Captured on a Topcon TRC-NW8 fundus camera — 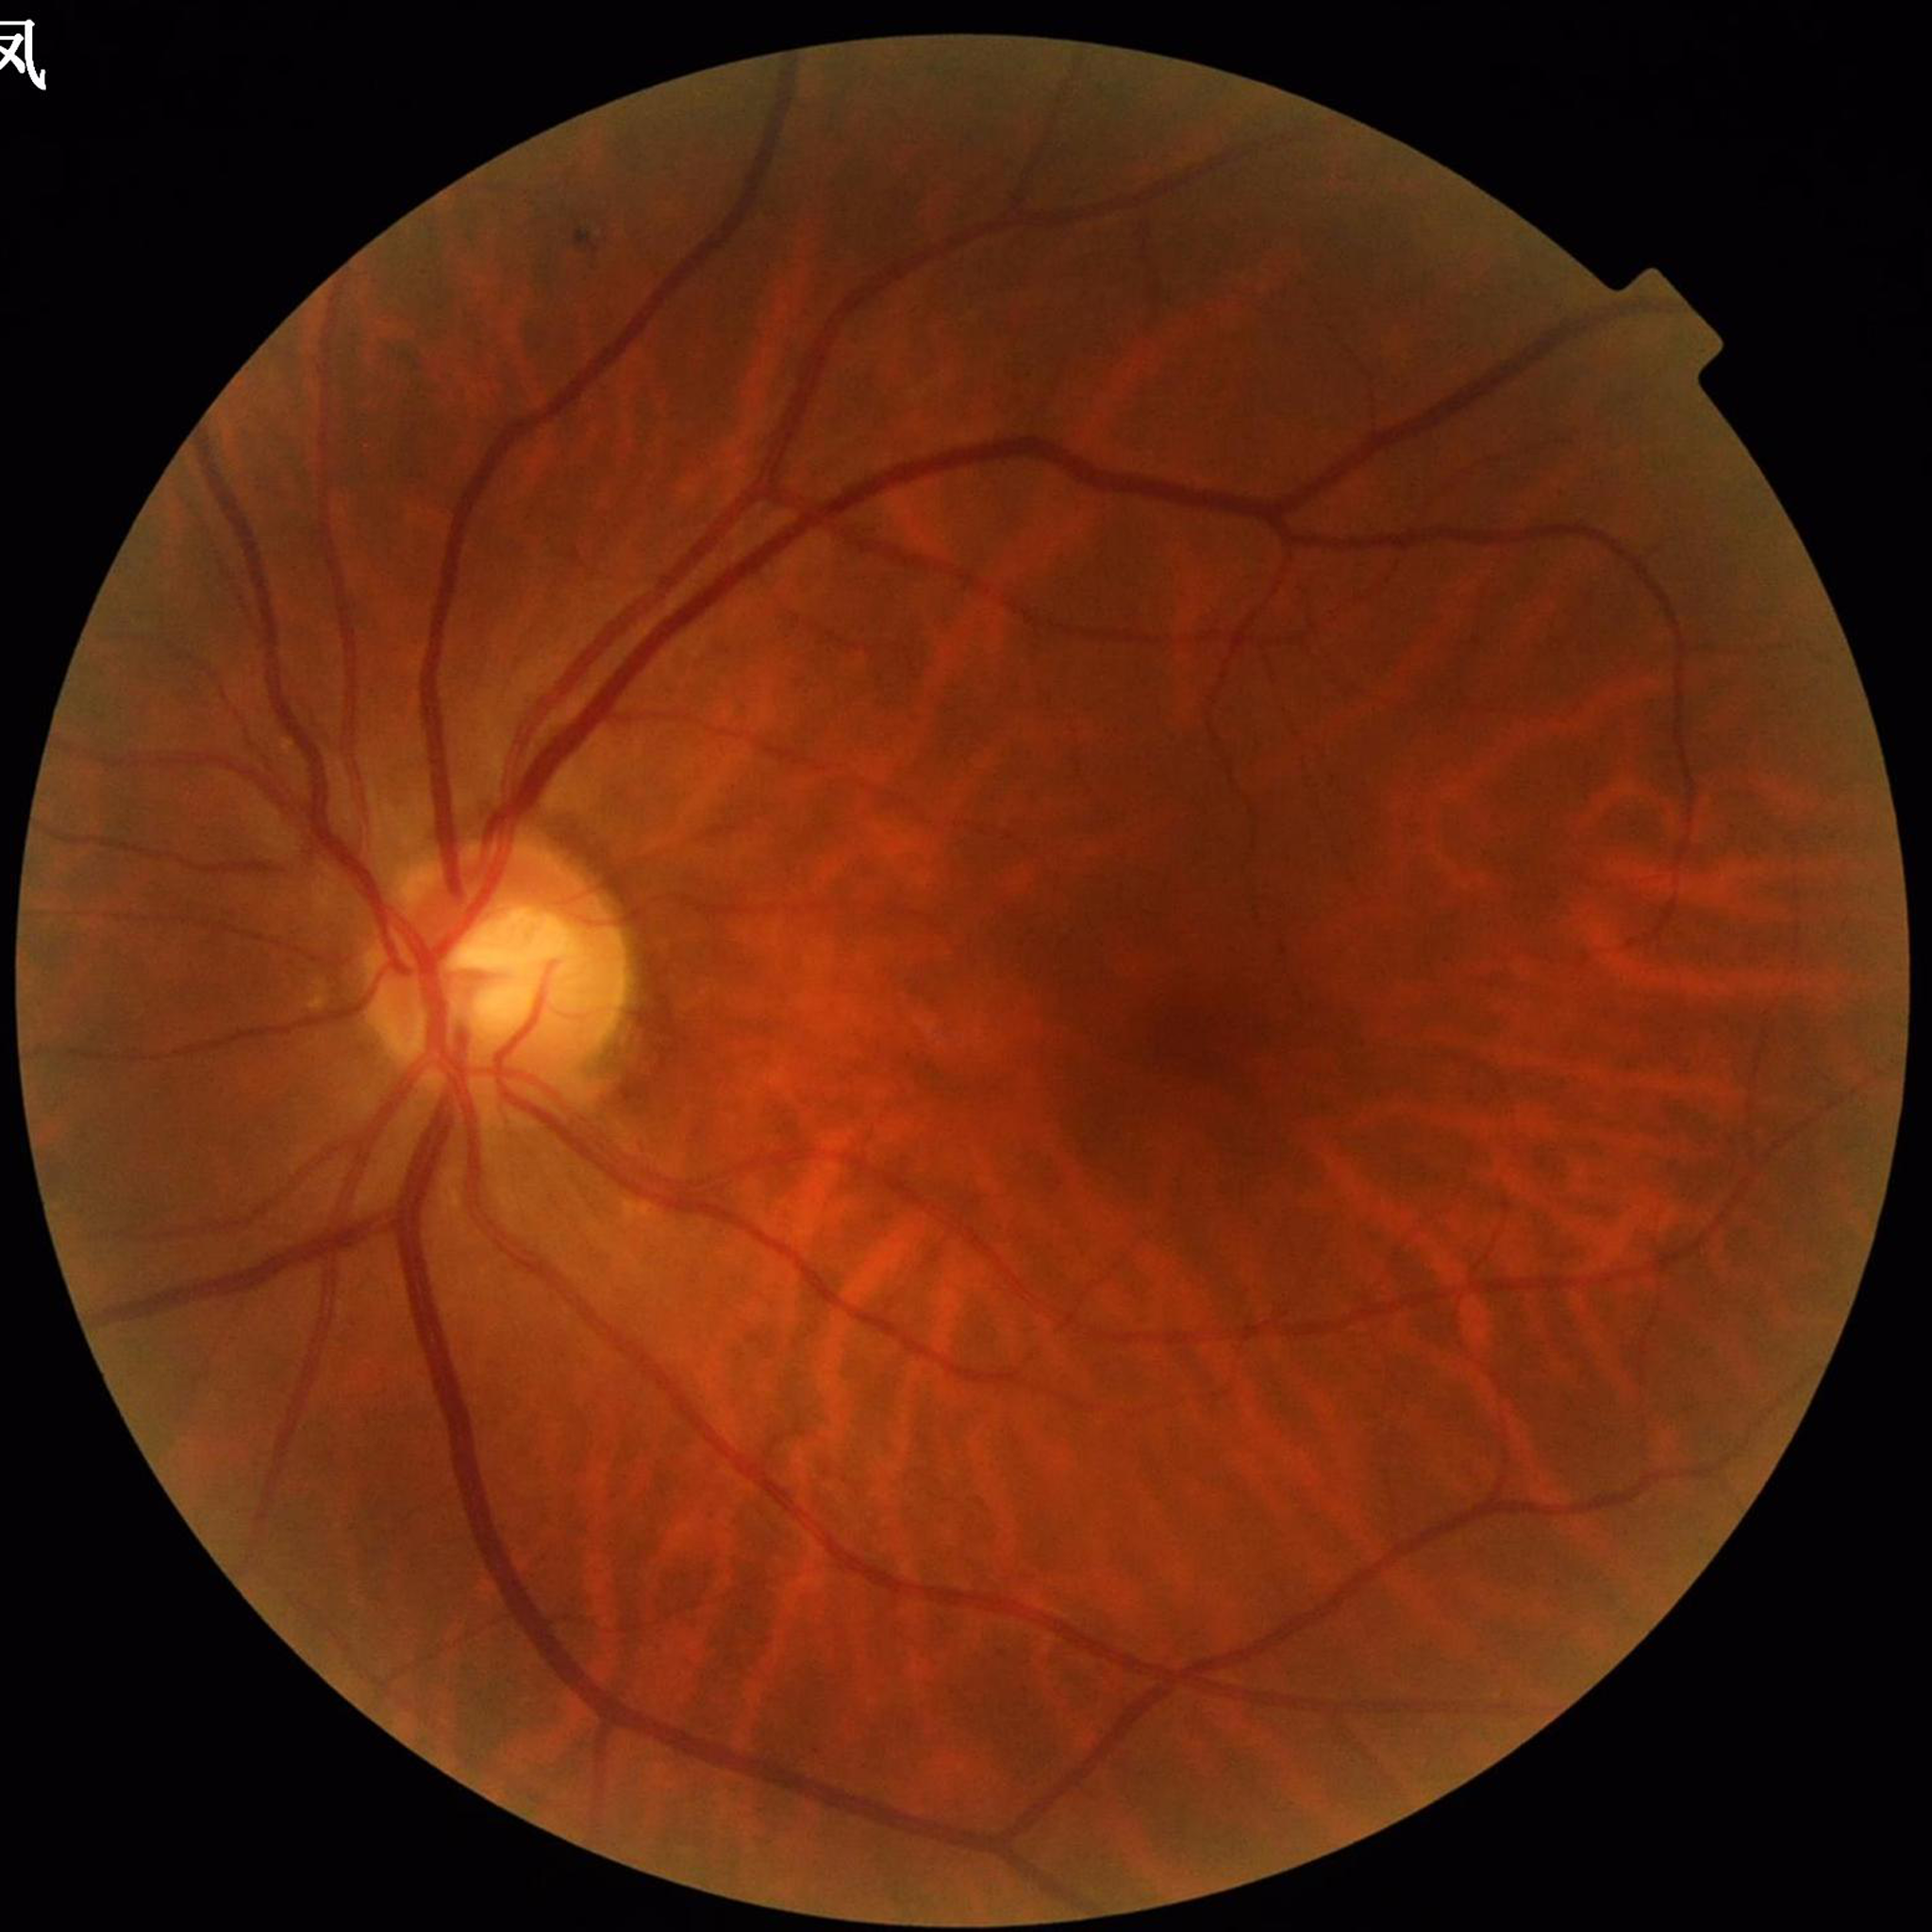
Patient diagnosed with diabetic retinopathy.